CFP: 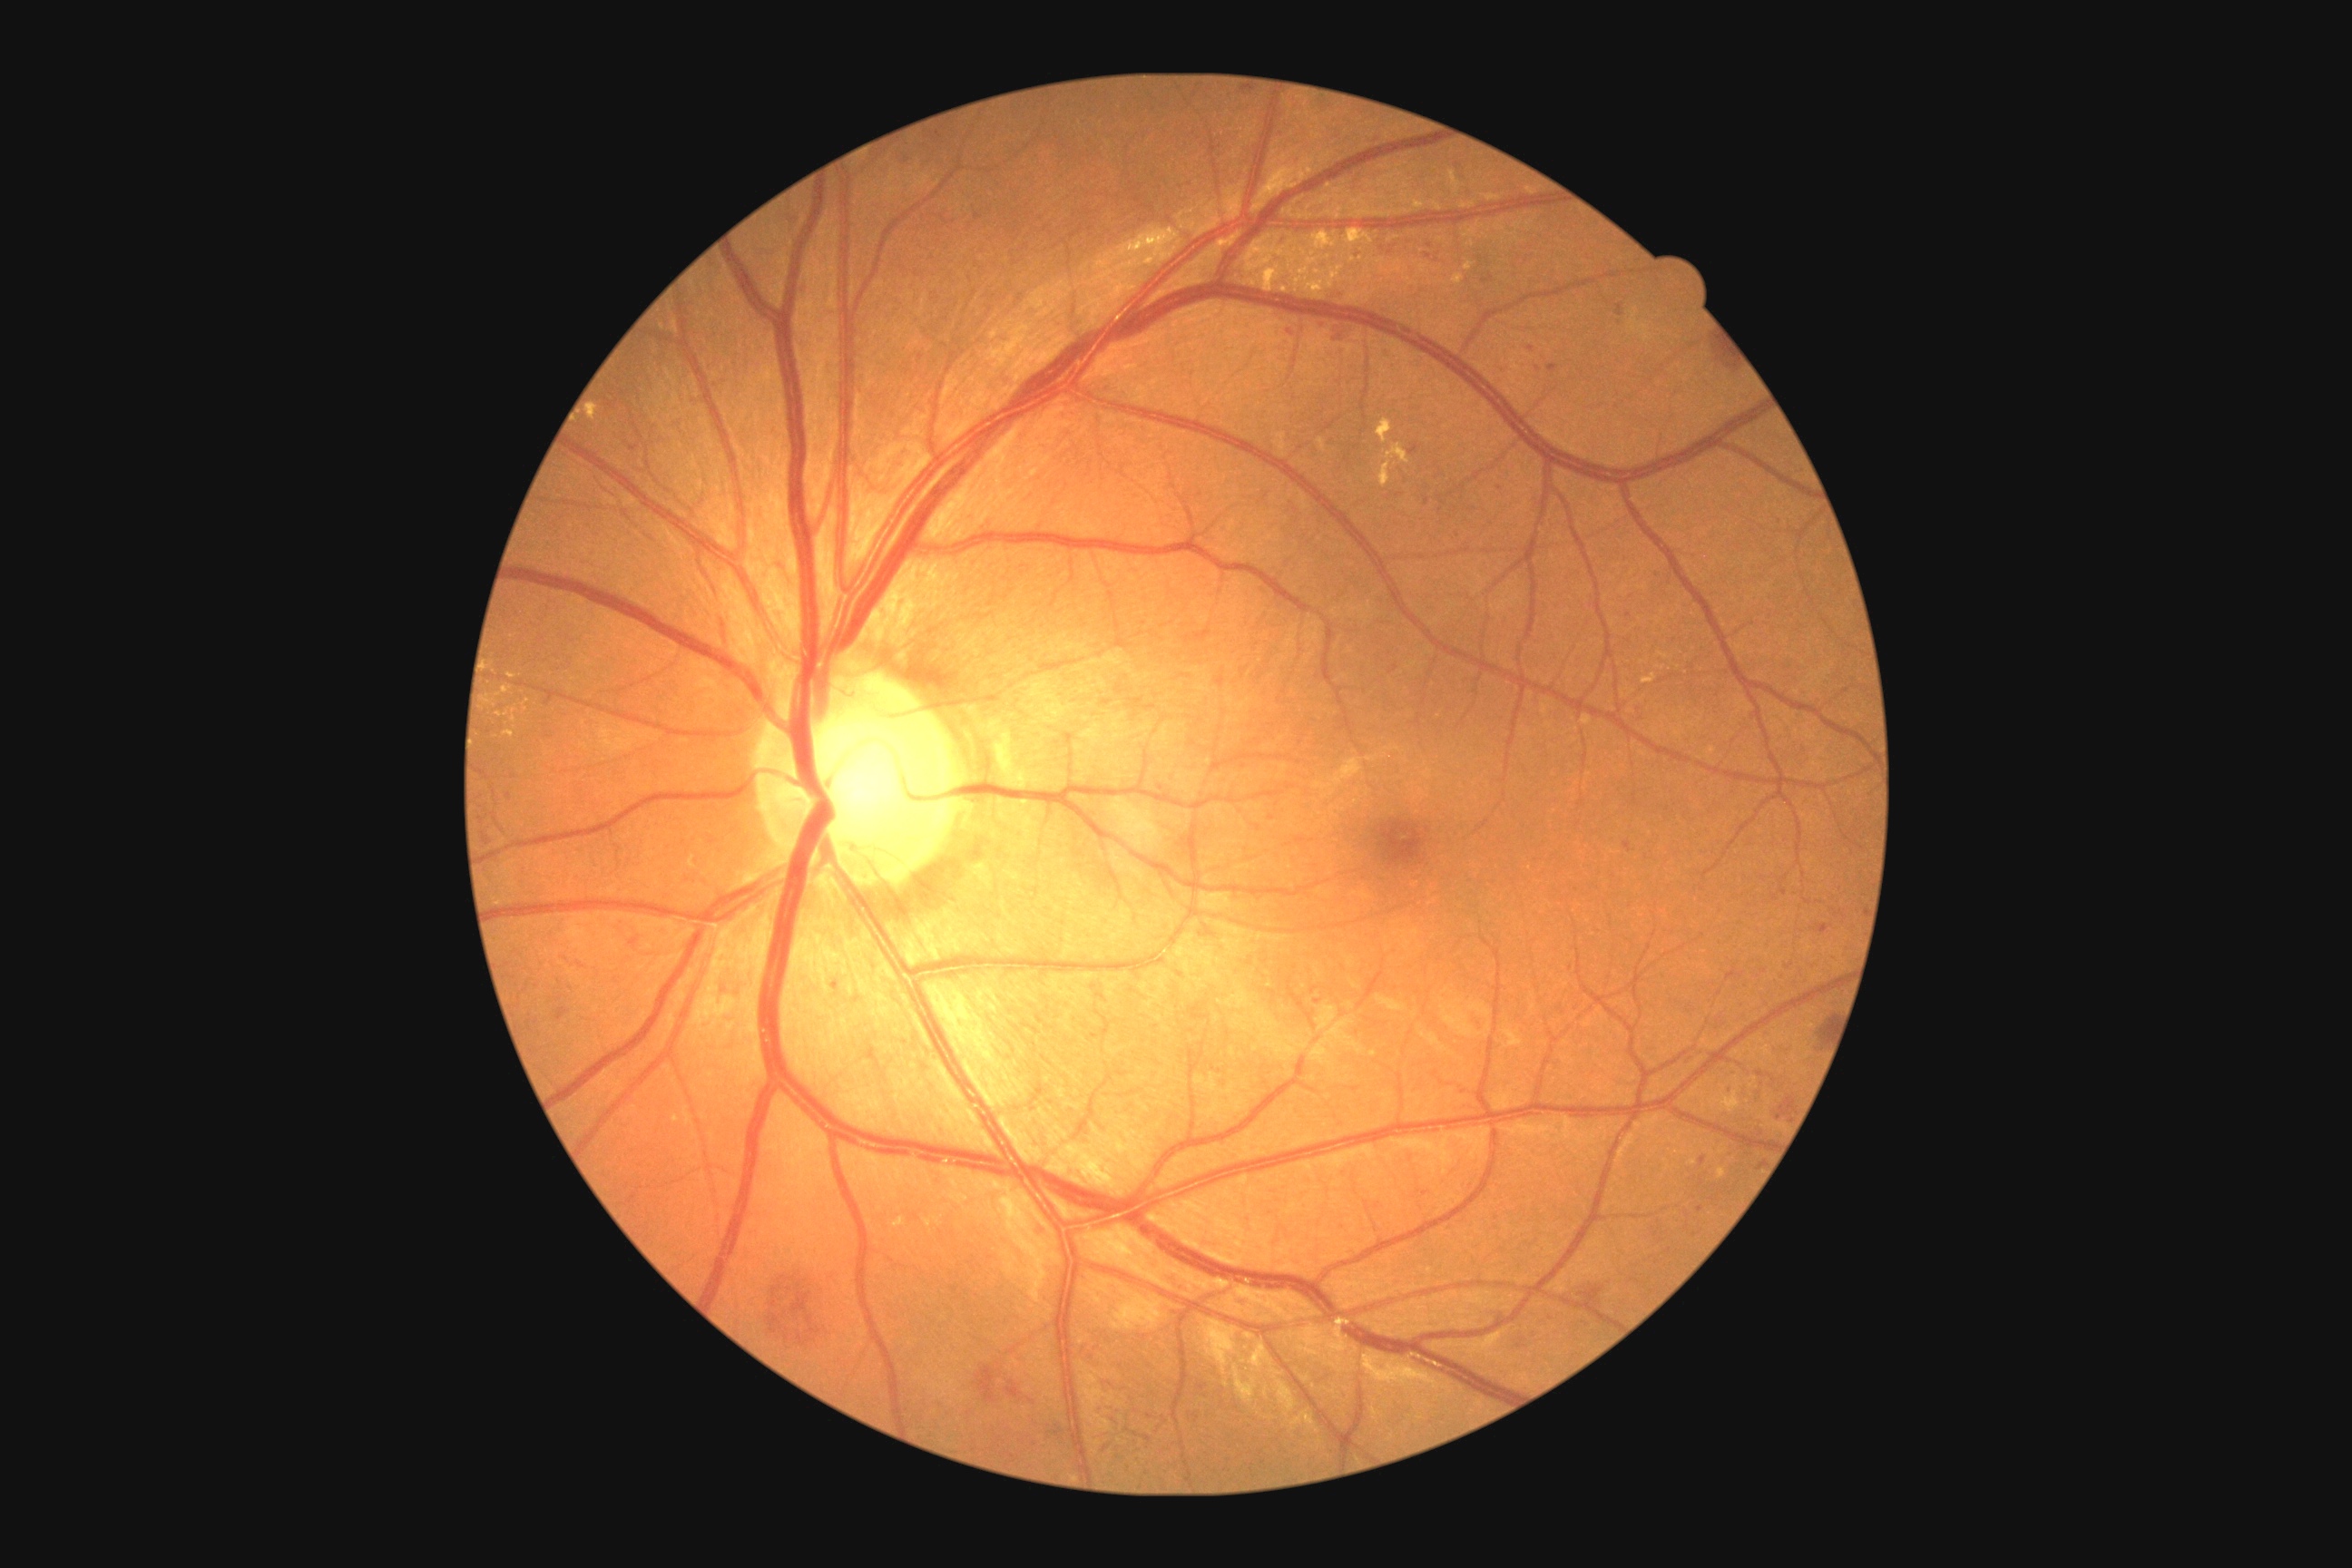 Diabetic retinopathy grade: 3 (severe NPDR)
Representative lesions:
hemorrhages (more not shown): 1752 1124 1767 1139 | 1741 1083 1749 1097 | 1770 1095 1798 1122 | 1353 250 1362 259 | 1612 302 1625 317 | 1776 974 1785 981 | 975 1364 1035 1407 | 1525 344 1536 353 | 781 210 801 231 | 1317 320 1326 328 | 1819 925 1828 934 | 1422 251 1436 262 | 1326 288 1346 304 | 1547 362 1560 373
Hemorrhages (small, approximate centers) near x=1427, y=502 | x=1728, y=1089 | x=1700, y=1210 | x=836, y=986
hard exudates (more not shown): 1349 231 1360 244 | 723 1006 727 1014 | 1380 464 1389 485 | 1378 420 1391 442 | 1128 230 1179 257 | 1433 202 1446 211 | 1219 242 1230 248 | 1266 270 1277 291 | 1643 680 1652 683
Hard exudates (small, approximate centers) near x=1352, y=259 | x=1459, y=280 | x=1298, y=282 | x=1249, y=257 | x=1304, y=176 | x=710, y=1003